Image size 2352x1568 · color fundus photograph: 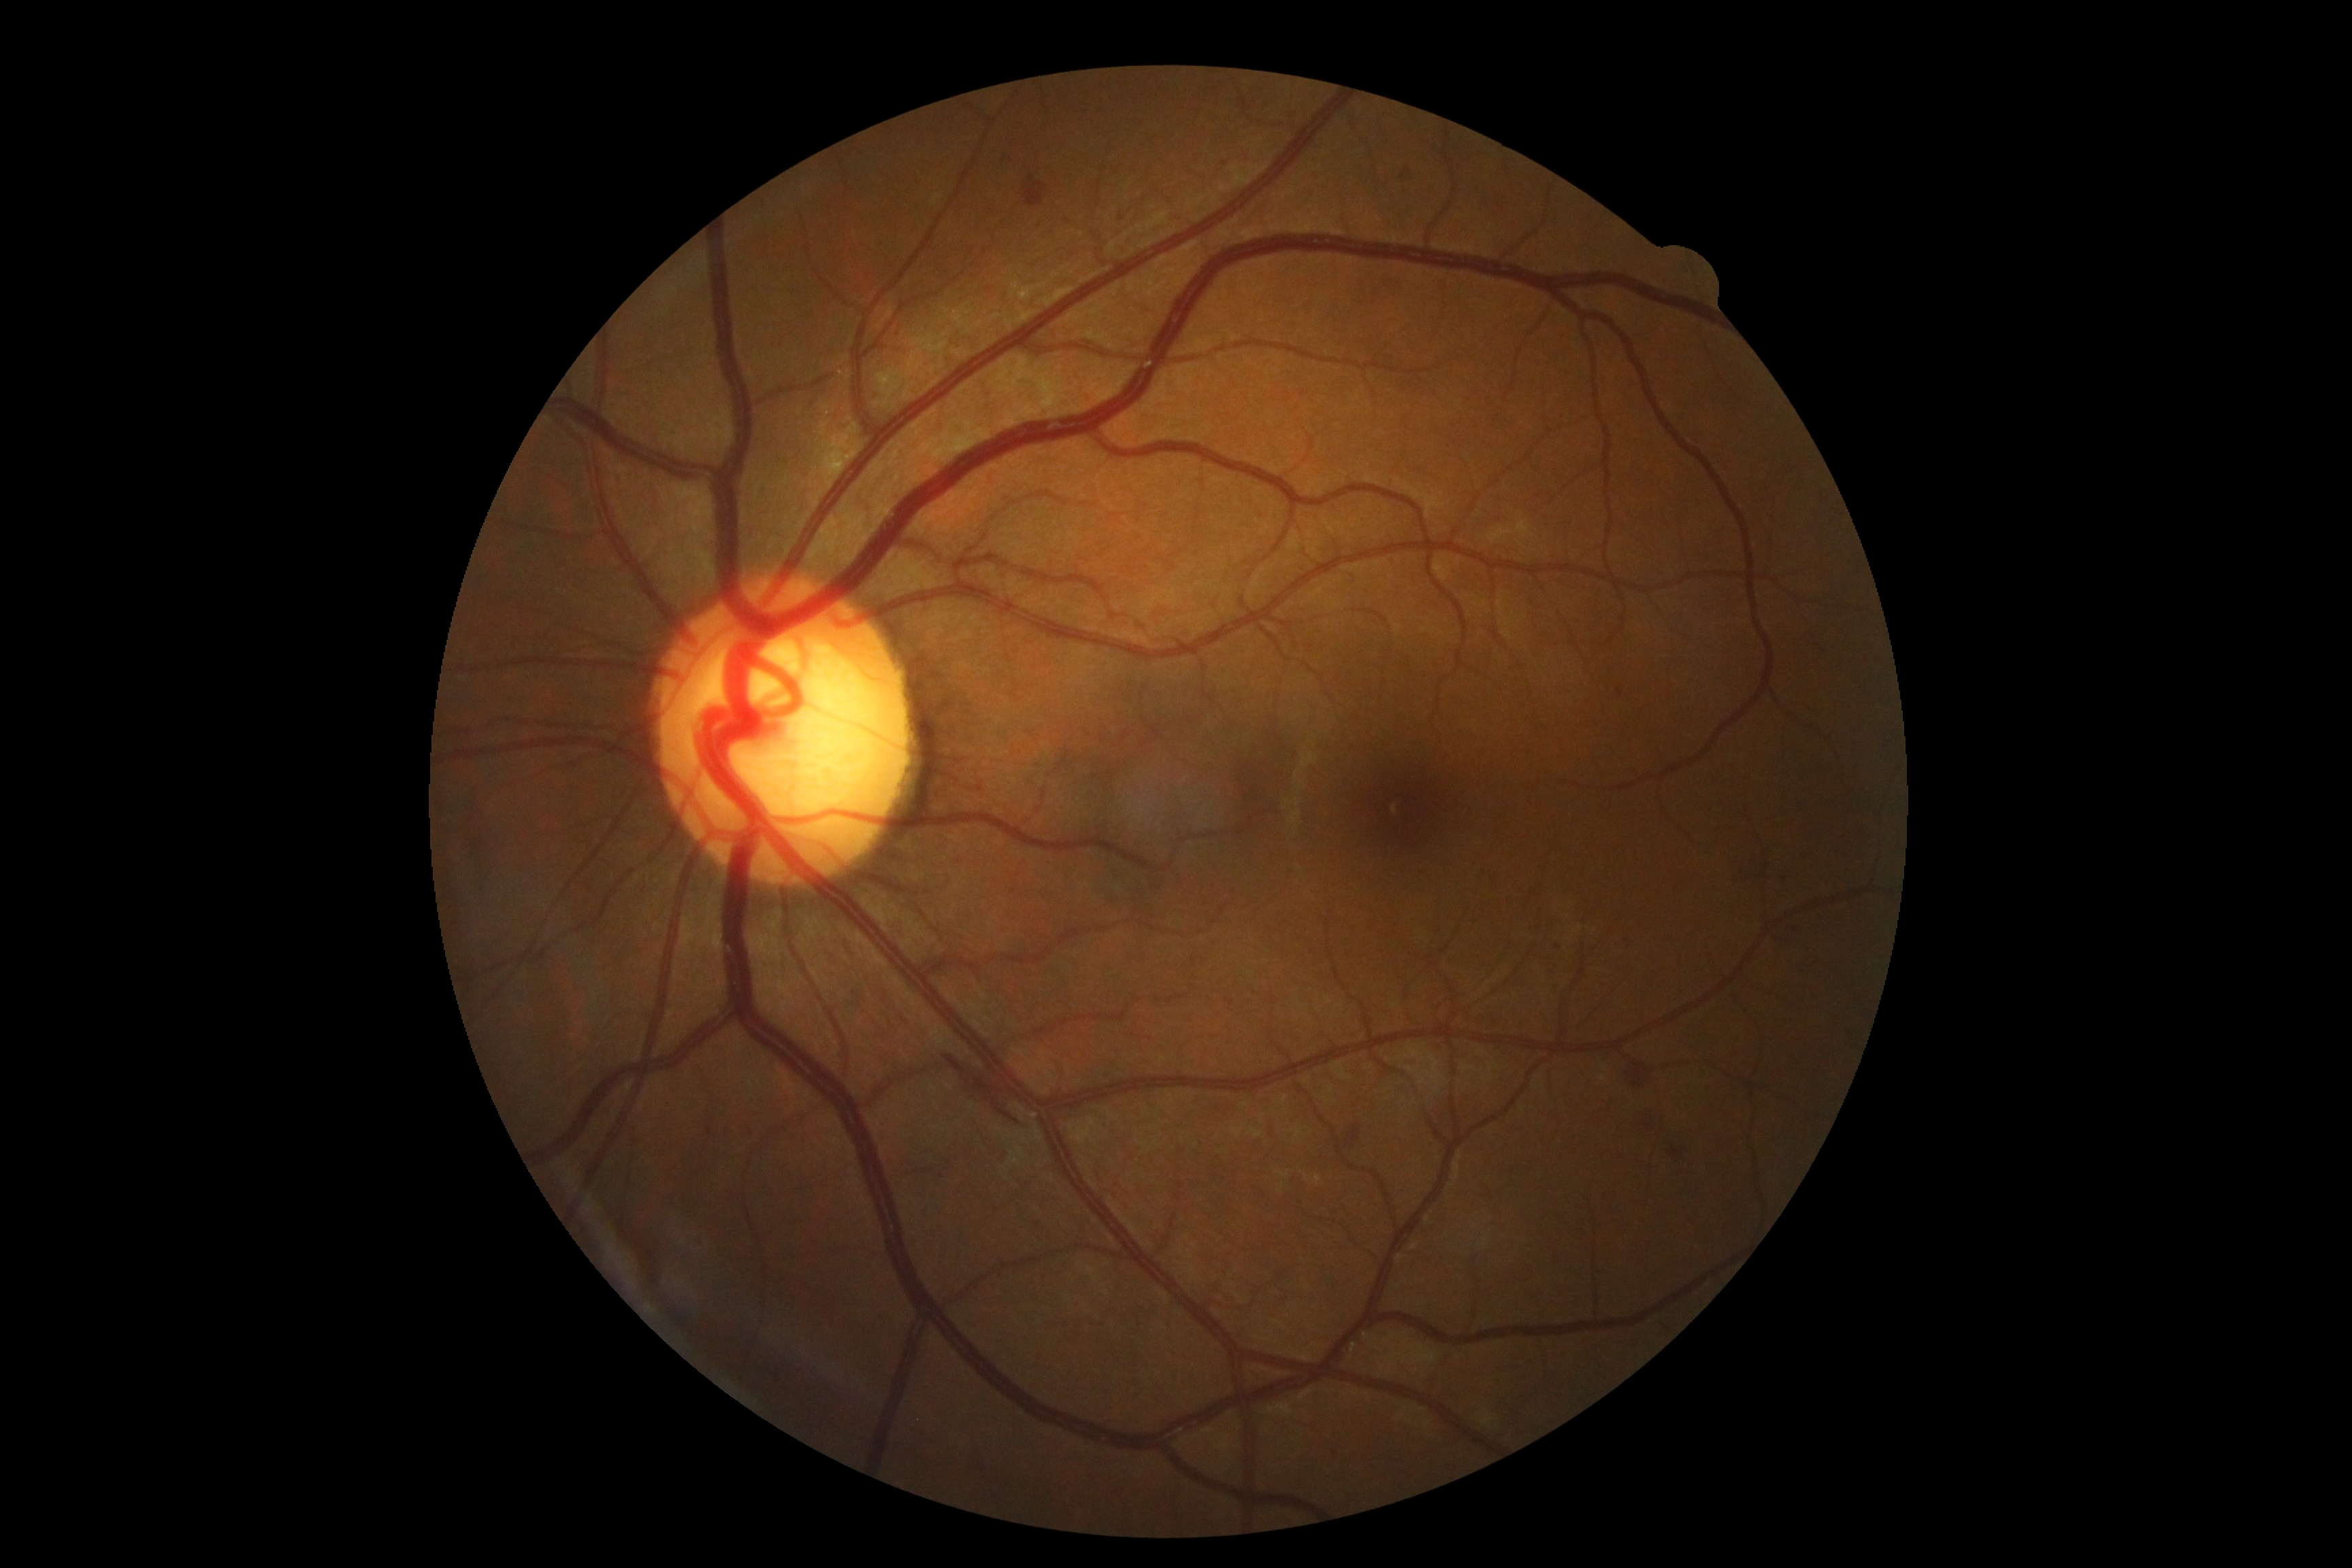 DR class: non-proliferative diabetic retinopathy.
DR severity: grade 2 (moderate NPDR) — more than just microaneurysms but less than severe NPDR.